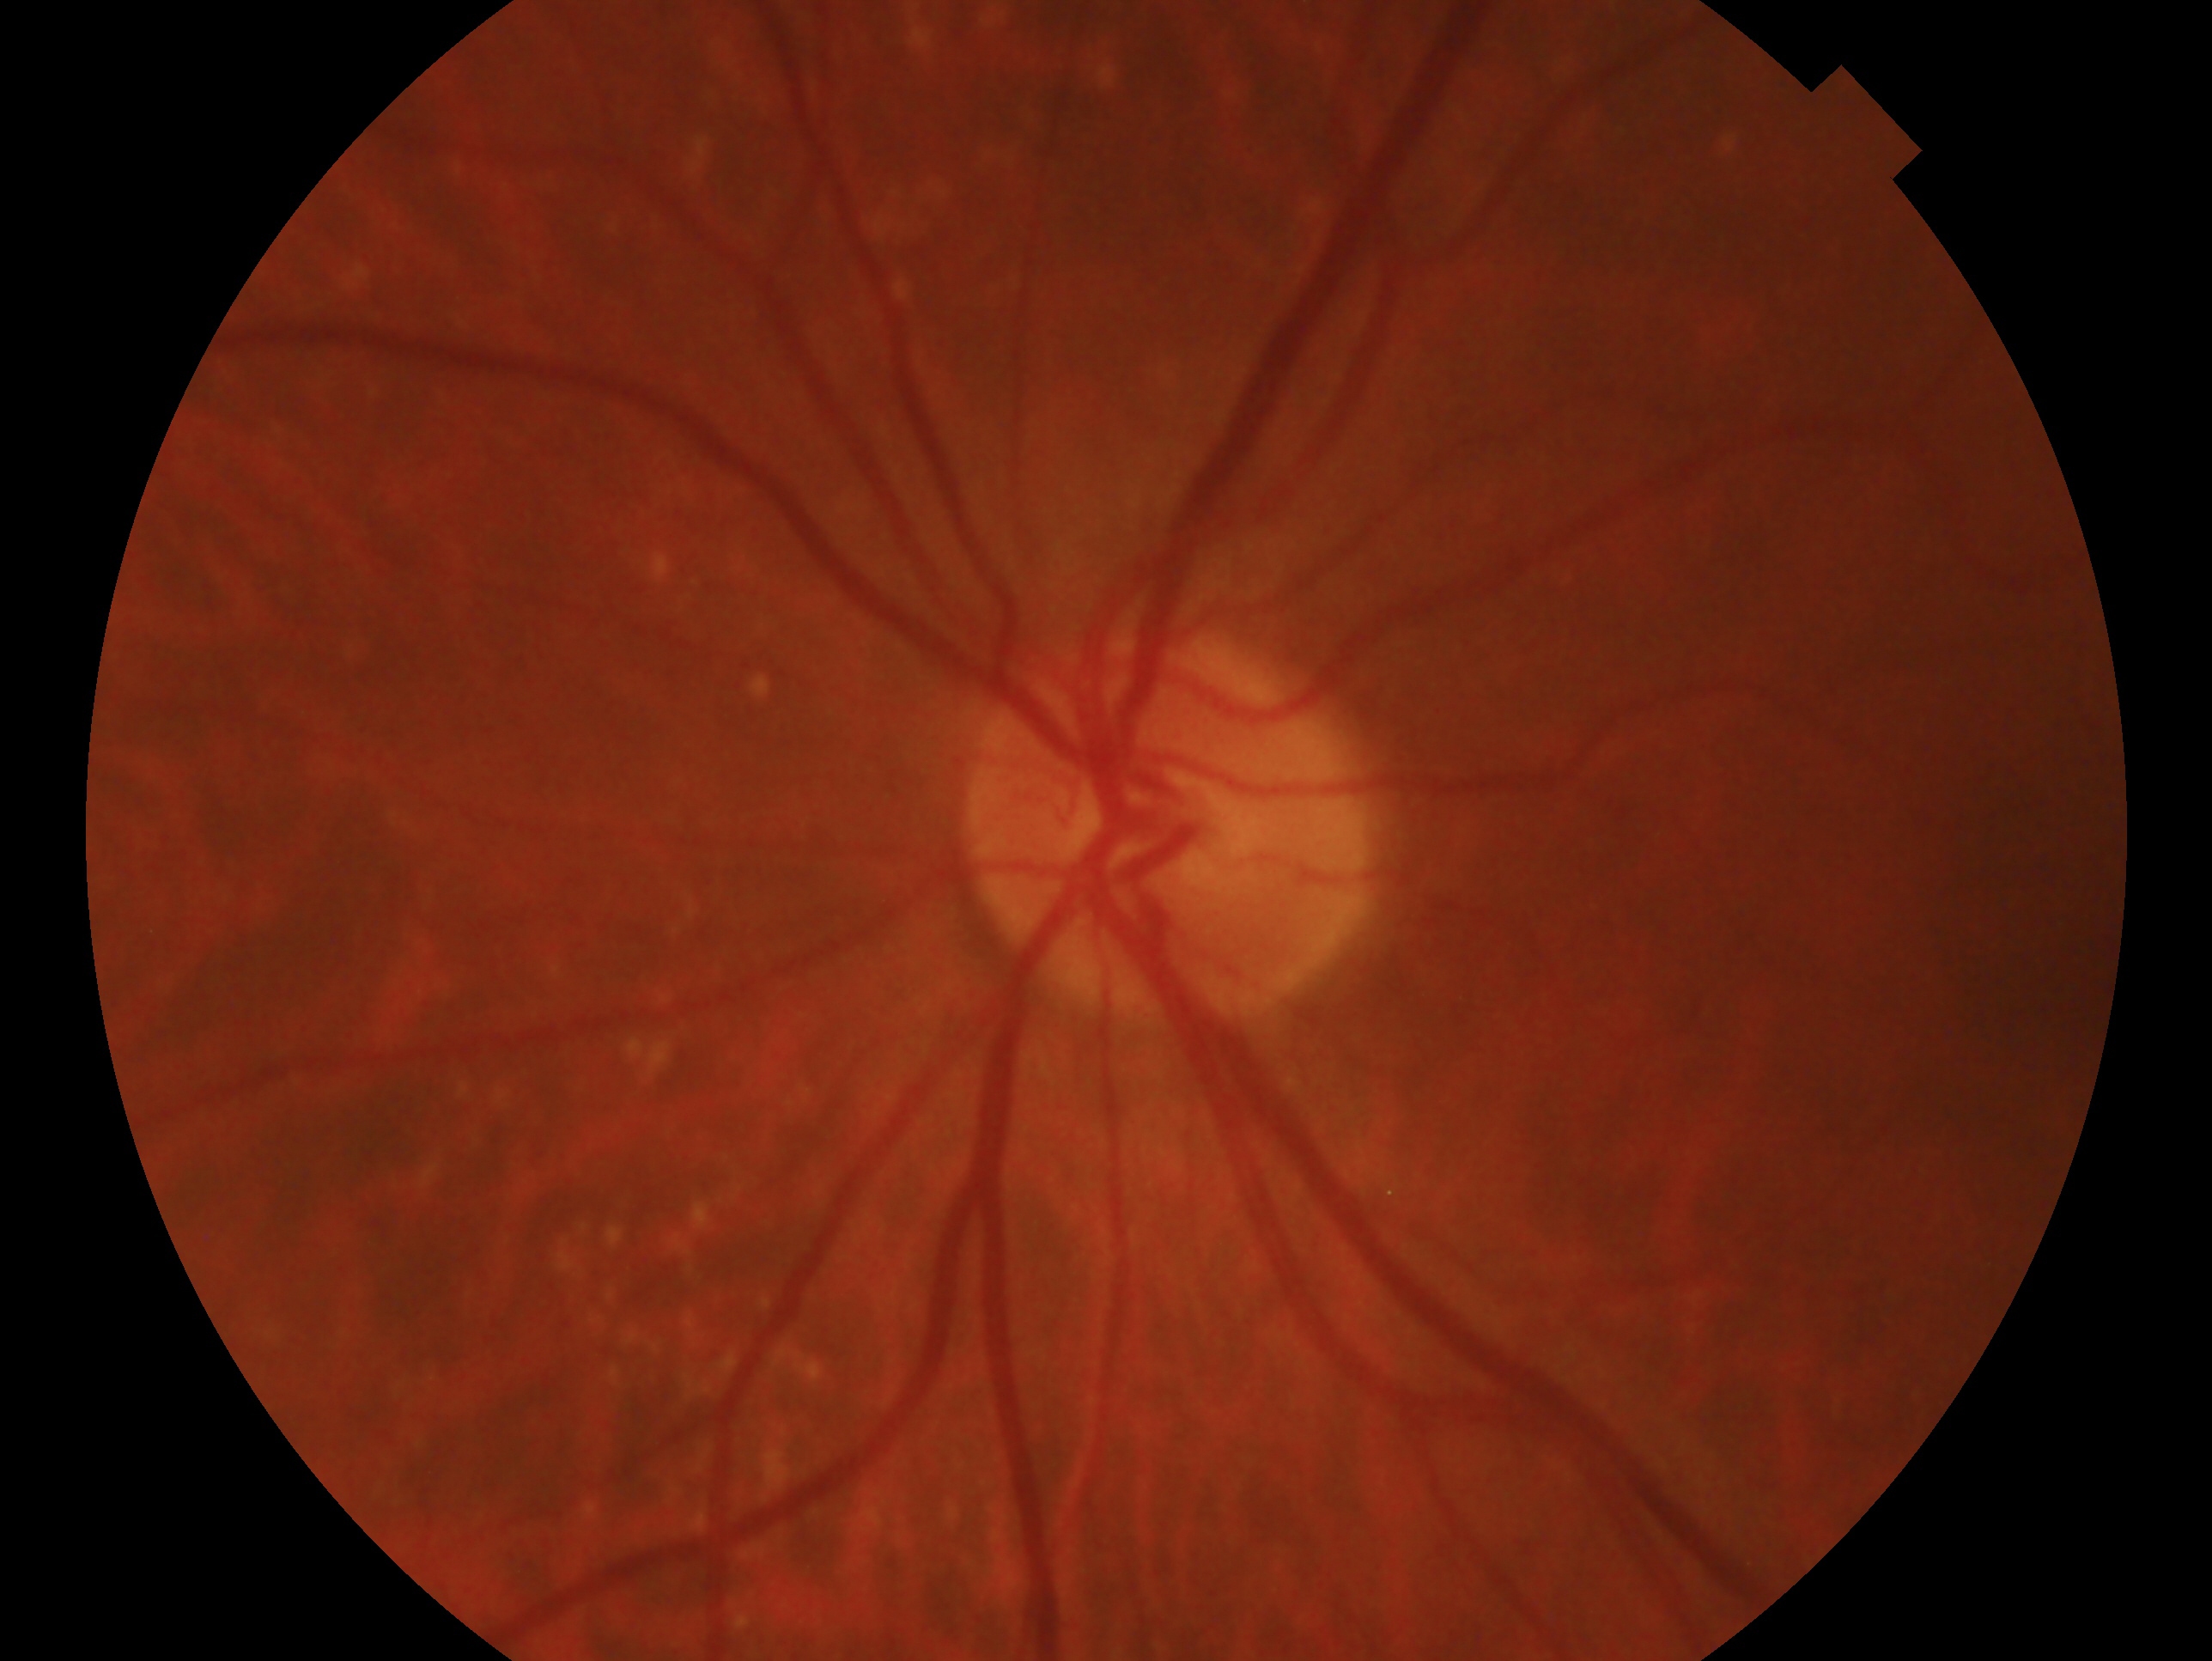 Glaucoma assessment: no glaucoma — no clinical evidence of glaucoma in this eye. Imaged eye: oculus sinister.